2212 by 1659 pixels · 45° field of view · retinal fundus photograph
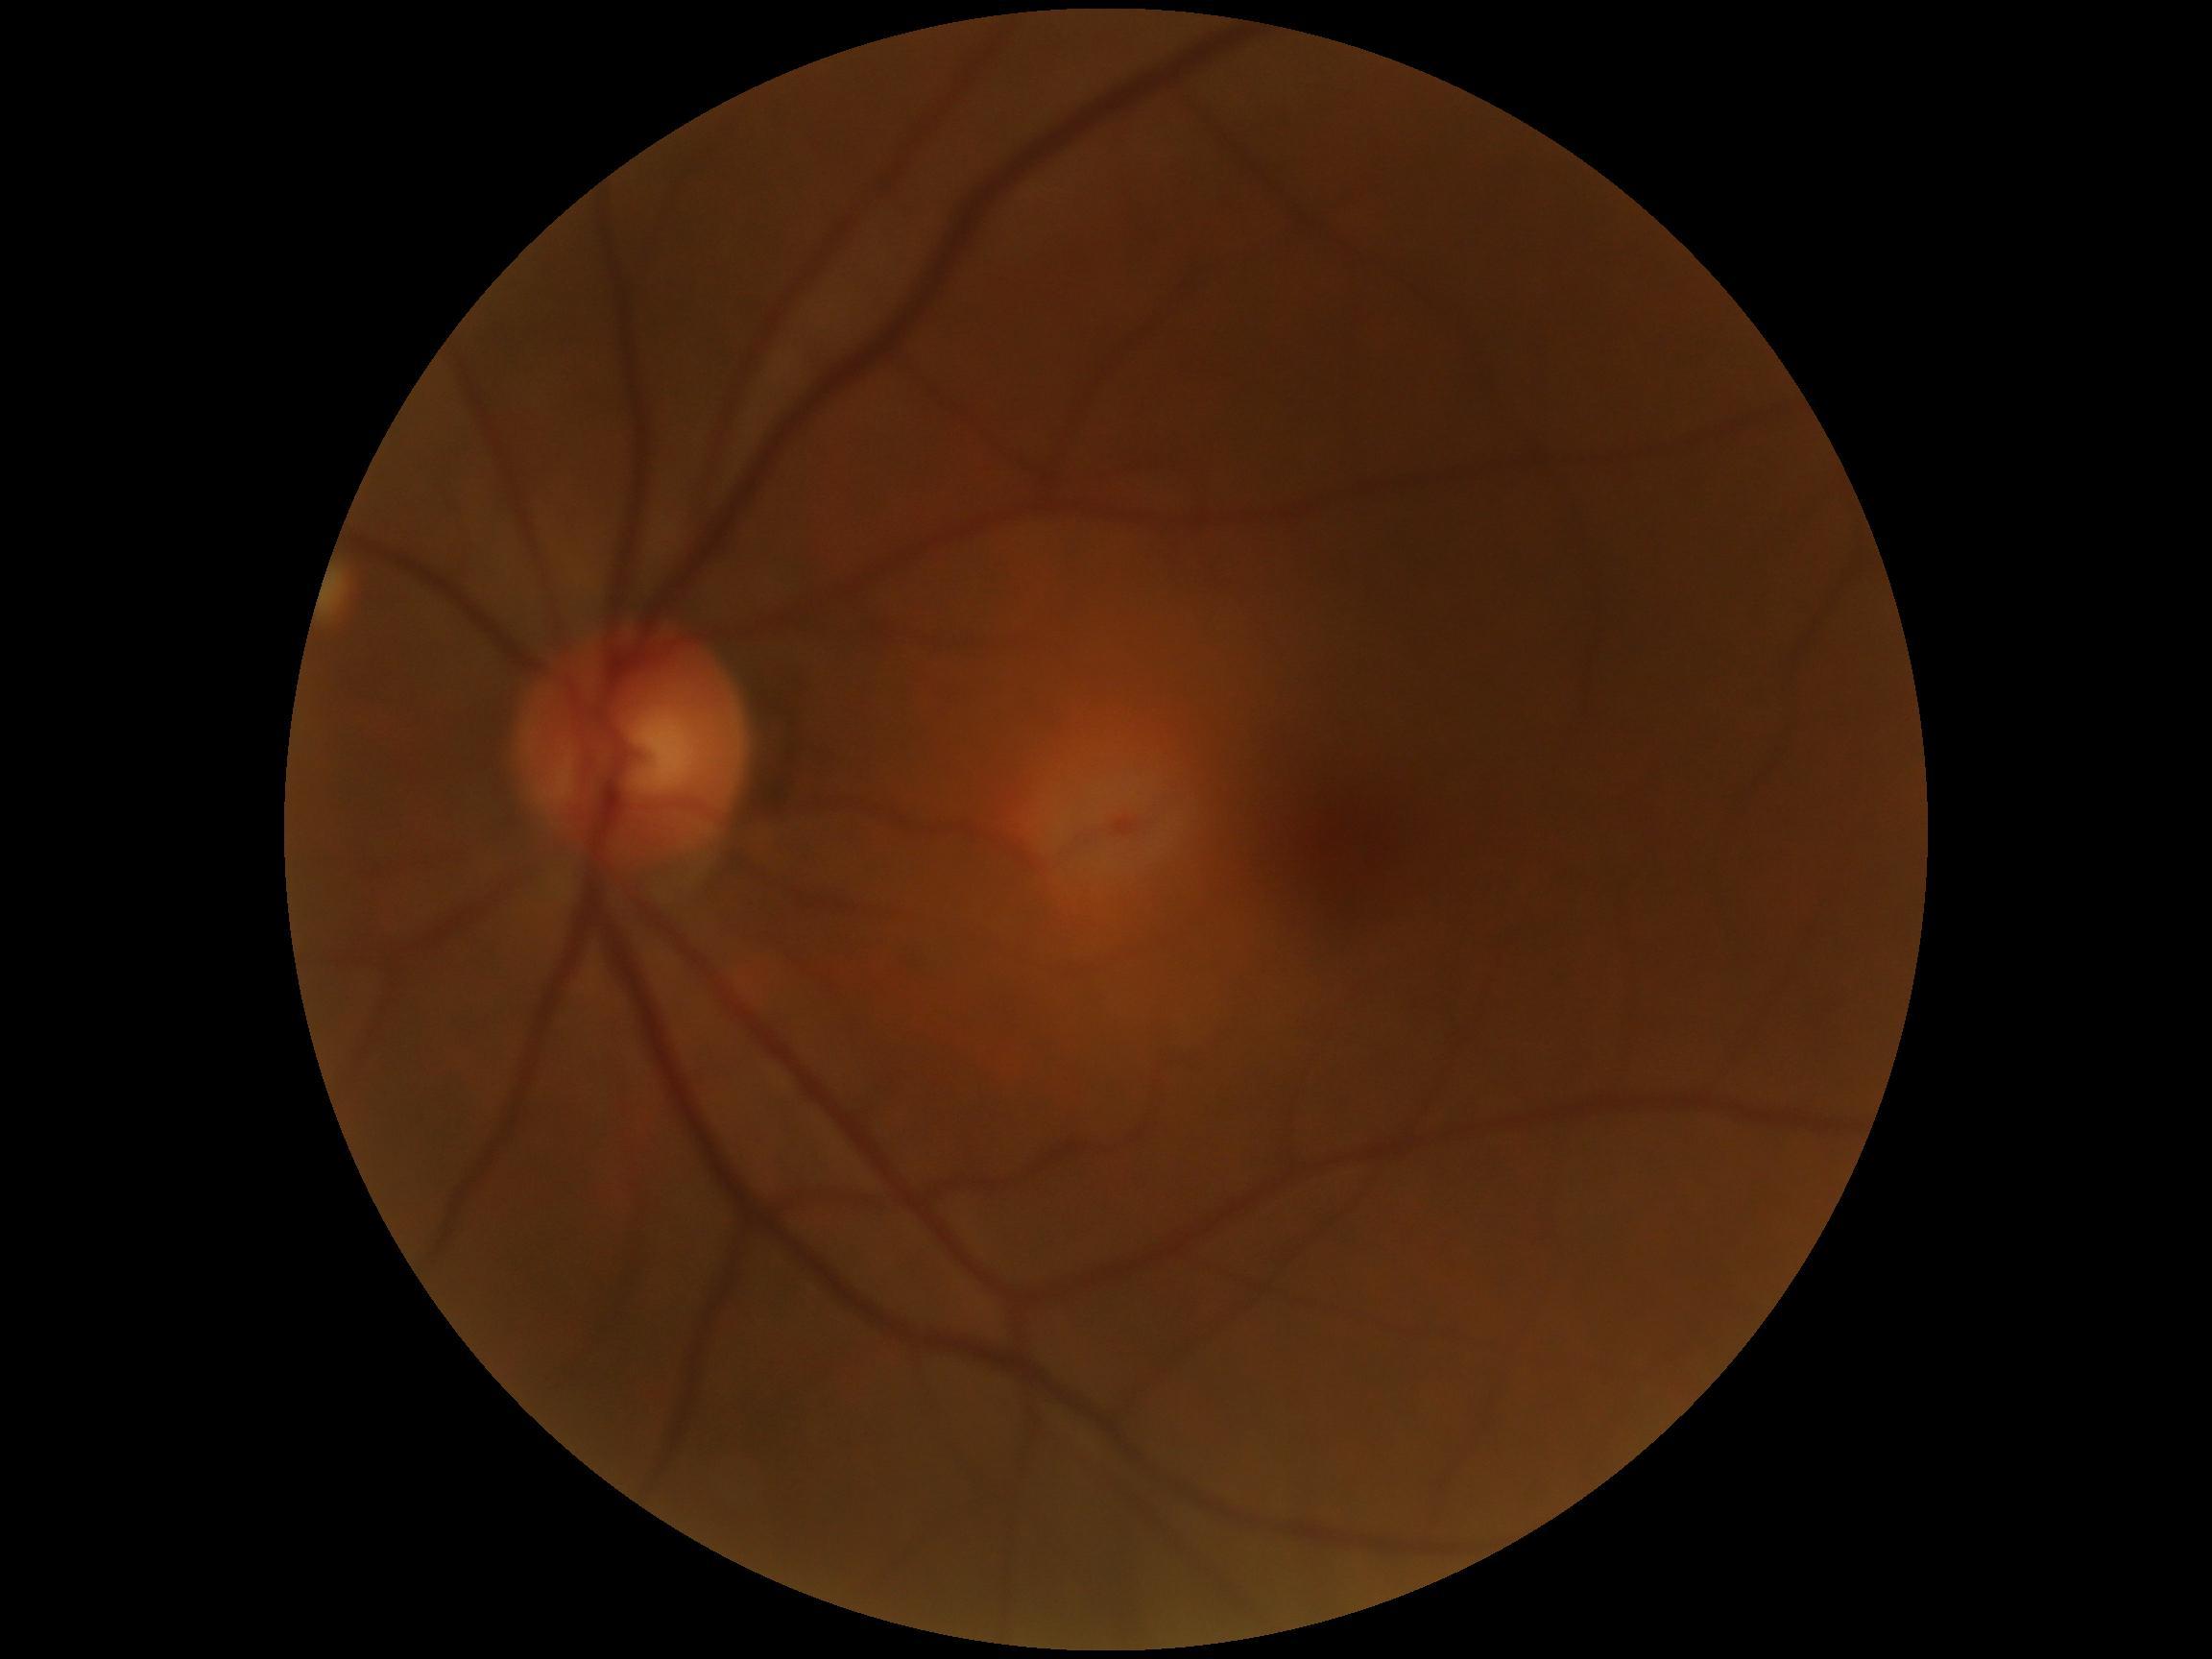 retinopathy grade = 0/4.